2048x1536 — 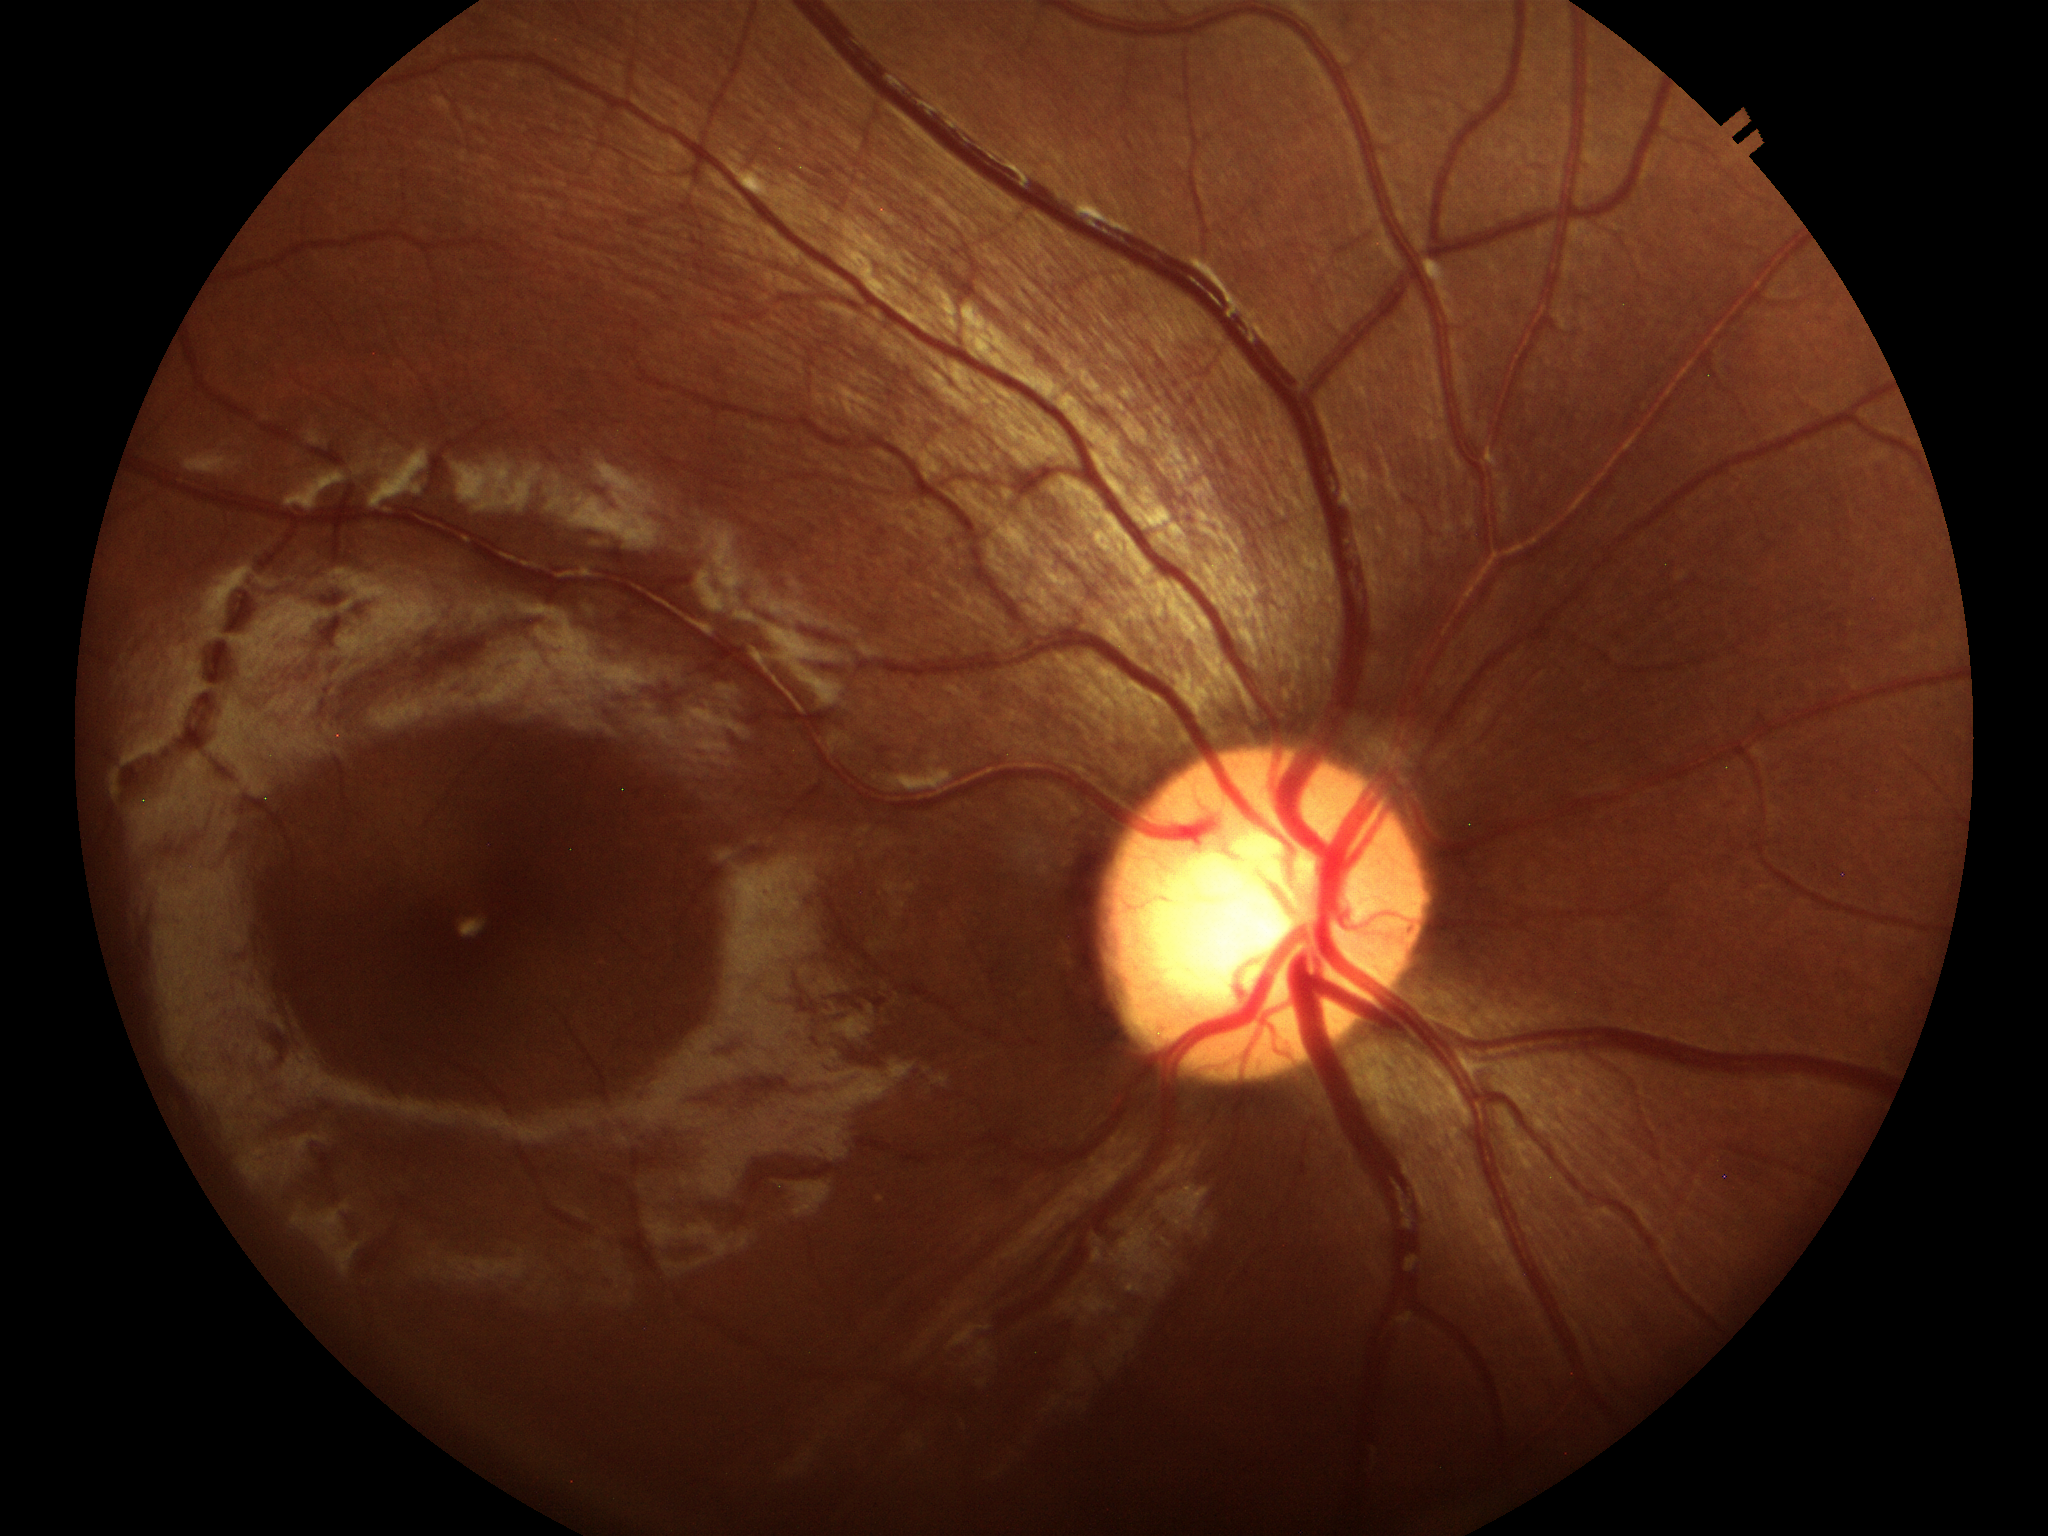 Optic disc analysis:
– Glaucoma decision: negative (one of five ophthalmologists flagged glaucoma suspect)
– vertical C/D ratio (VCDR): 0.56
– horizontal cup-to-disc ratio (HCDR): 0.59